1240x1240px; wide-field fundus photograph from neonatal ROP screening; captured with the Phoenix ICON (100° field of view):
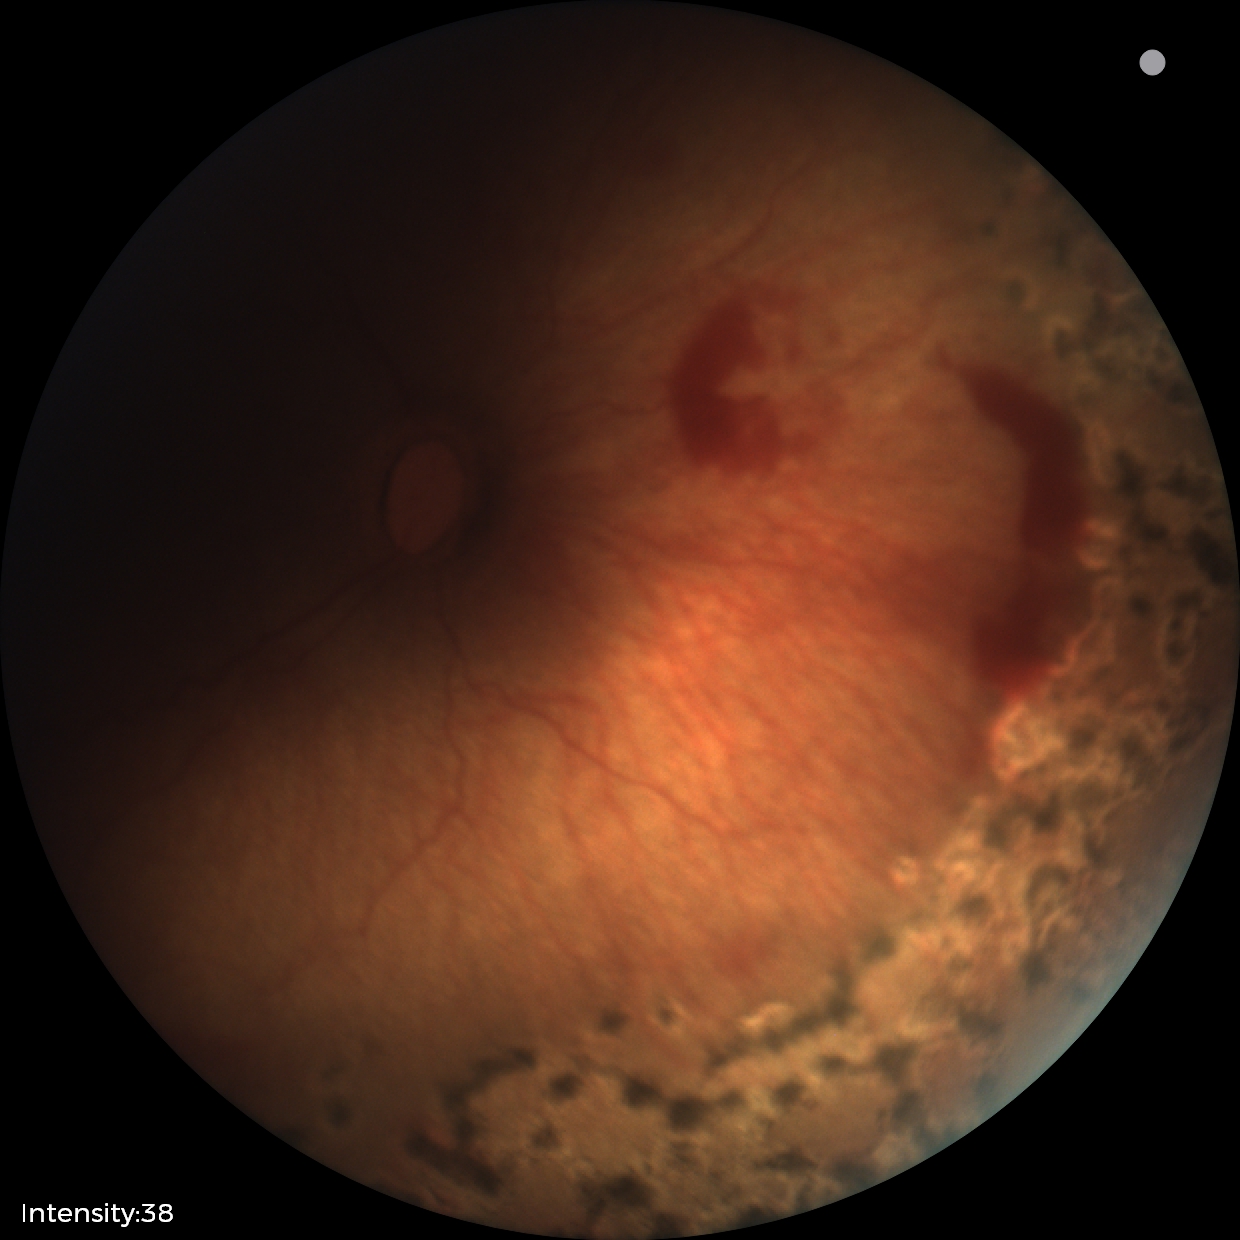

Diagnosis from this screening exam: status post retinopathy of prematurity. No plus disease.